45-degree field of view — 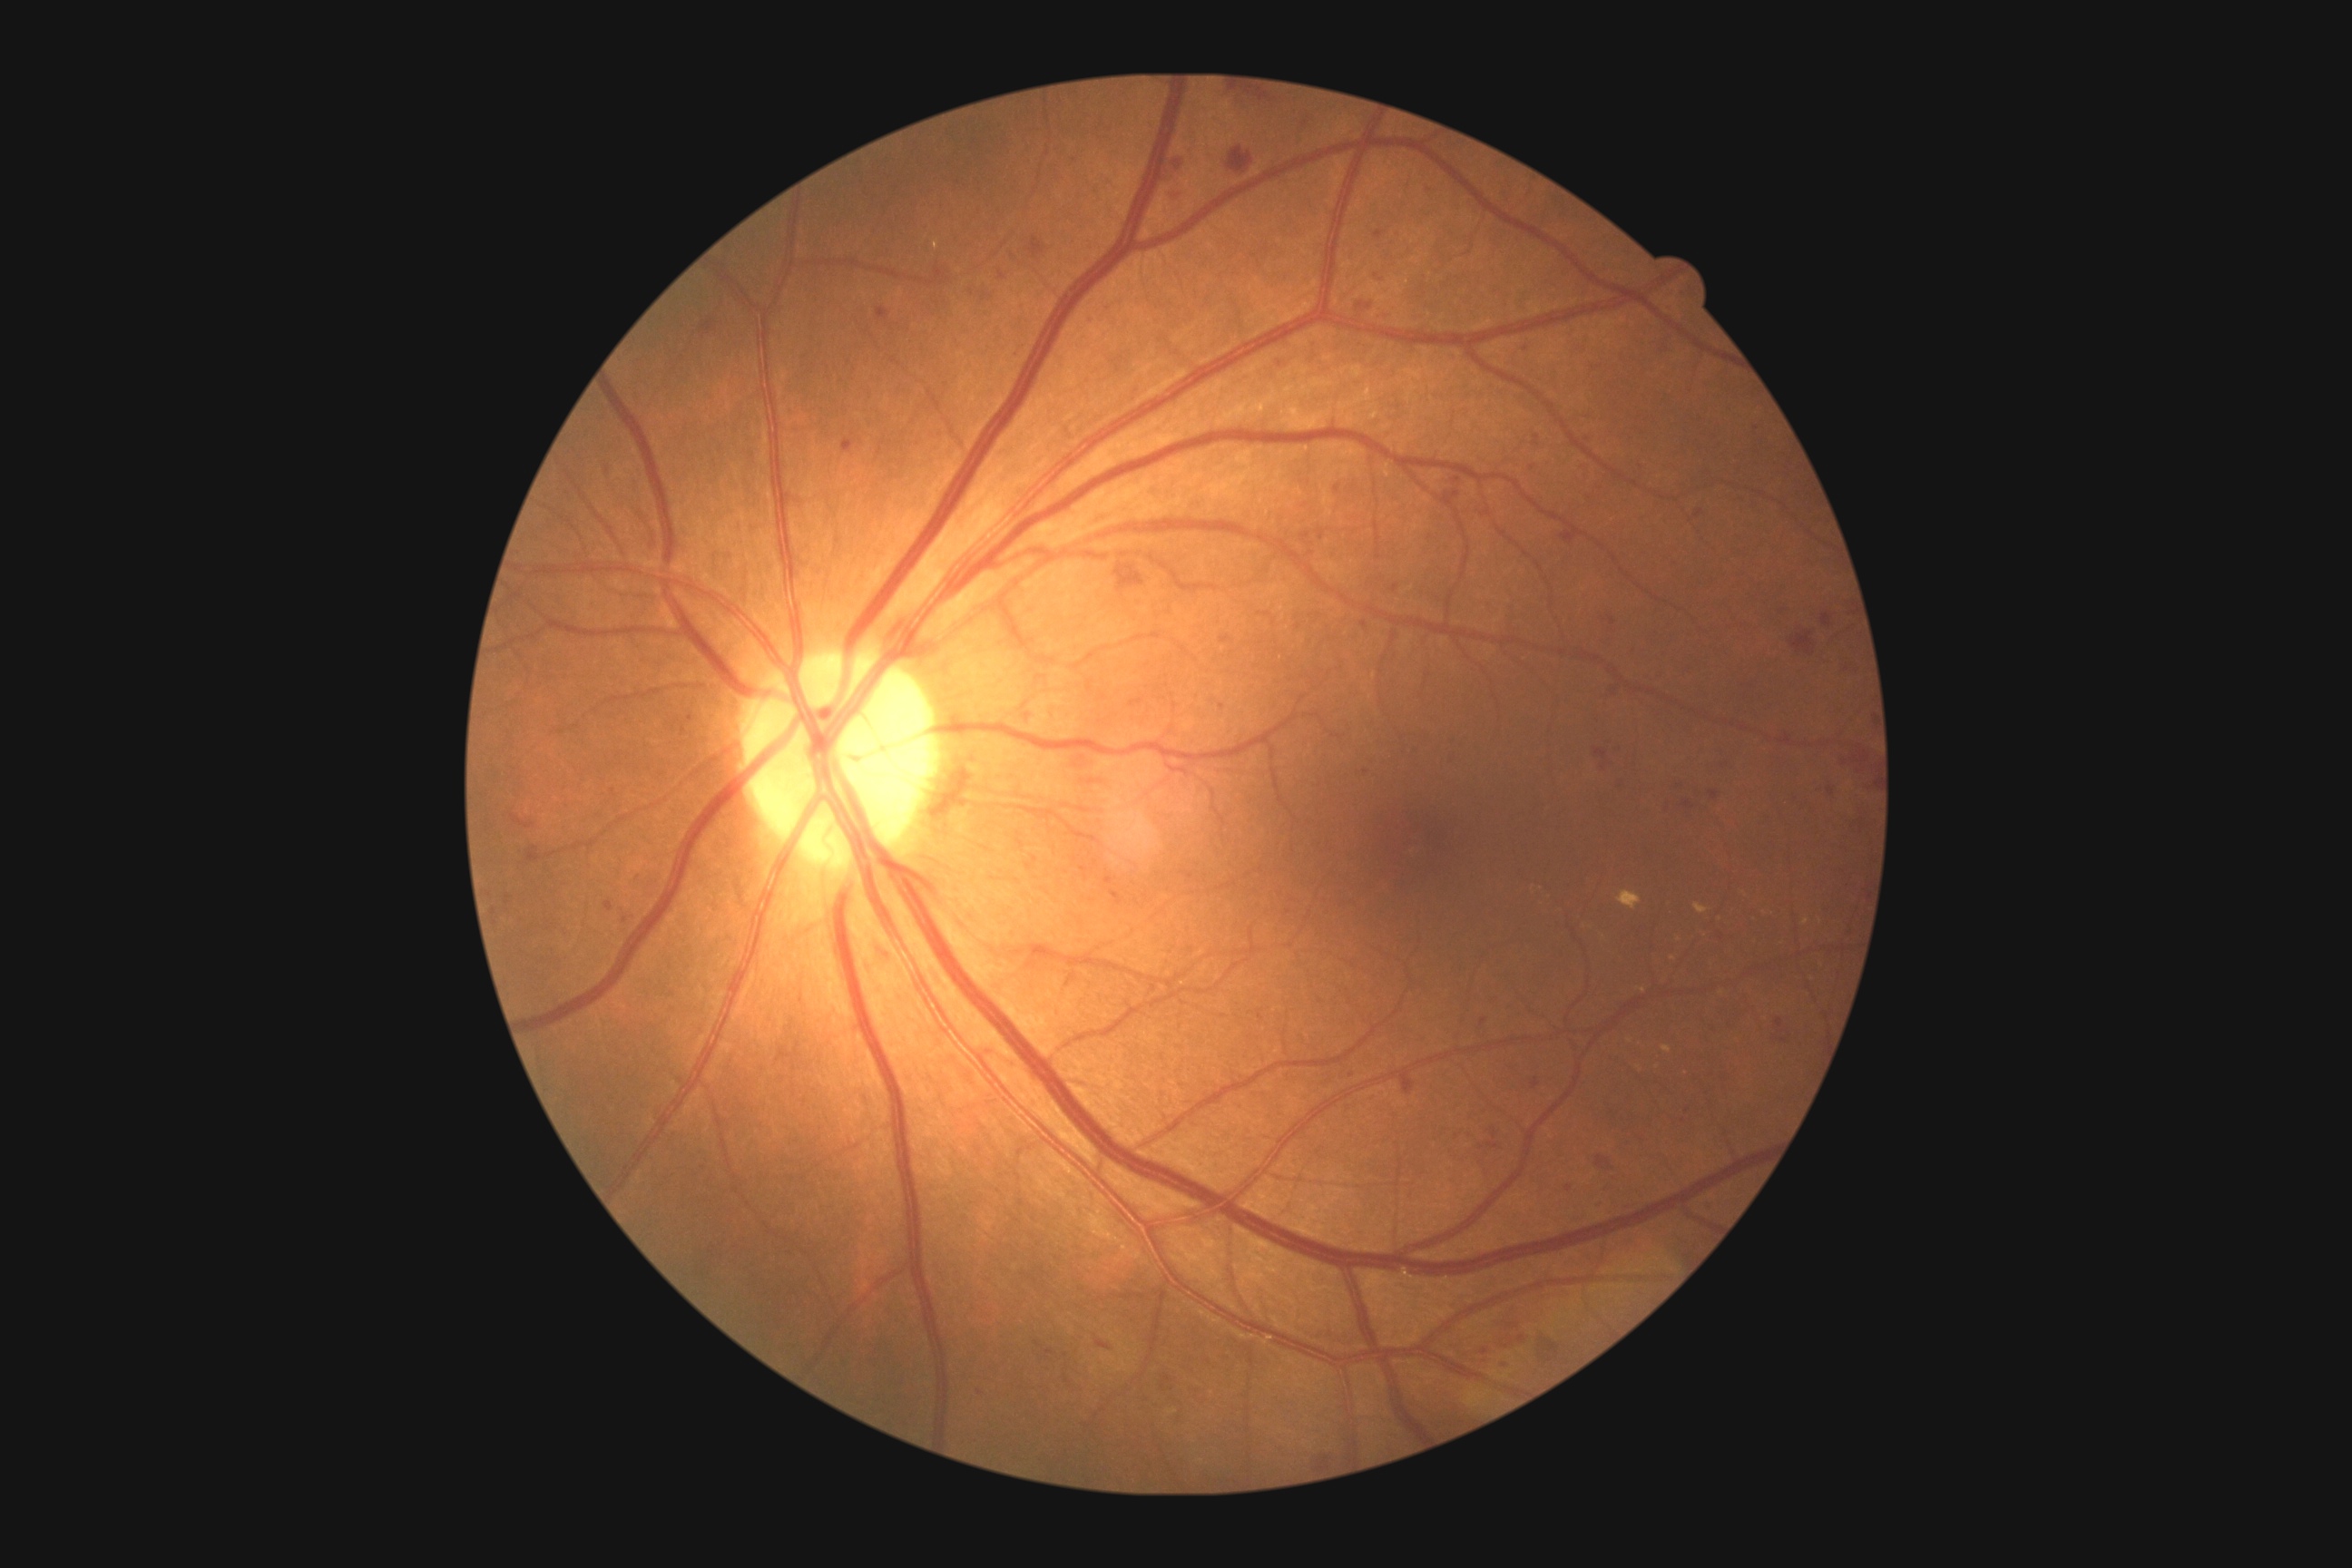
Retinopathy is moderate non-proliferative diabetic retinopathy (grade 2) — more than just microaneurysms but less than severe NPDR
A subset of detected lesions:
- hard exudates (continued): 1618:890:1642:910; 1694:903:1709:914; 1661:1046:1672:1054; 934:240:939:250; 1638:988:1647:994
- Small hard exudates approximately at (x=1630, y=1041); (x=1673, y=958); (x=1806, y=922); (x=1722, y=993); (x=1640, y=1068)
- soft exudates: none
- hemorrhages (continued): 1104:304:1112:311; 1391:583:1400:593; 1836:747:1874:792; 841:438:854:455; 1373:231:1386:240; 1558:529:1585:545; 1594:749:1607:760; 1651:331:1678:355; 1487:994:1504:1008; 1161:153:1186:184; 1362:622:1367:631; 1603:681:1622:700; 631:870:642:885; 977:1391:985:1395; 999:271:1006:280; 611:789:622:798
- Small hemorrhages approximately at (x=496, y=923); (x=1603, y=768); (x=633, y=917); (x=673, y=994)
- microaneurysms: none